Camera: Clarity RetCam 3 (130° FOV); pediatric wide-field fundus photograph — 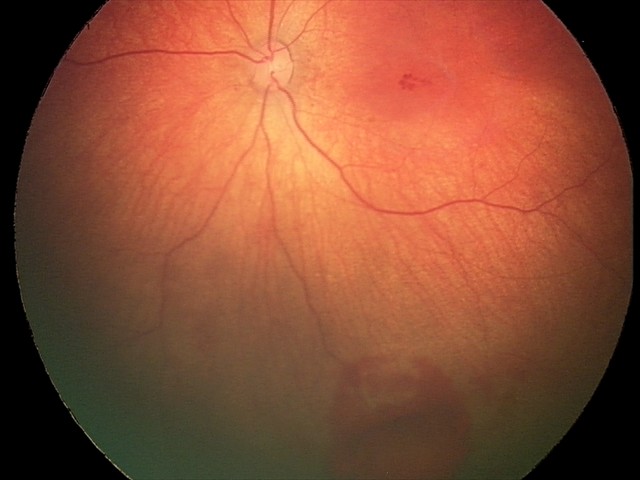 Screening diagnosis: retinal hemorrhages.